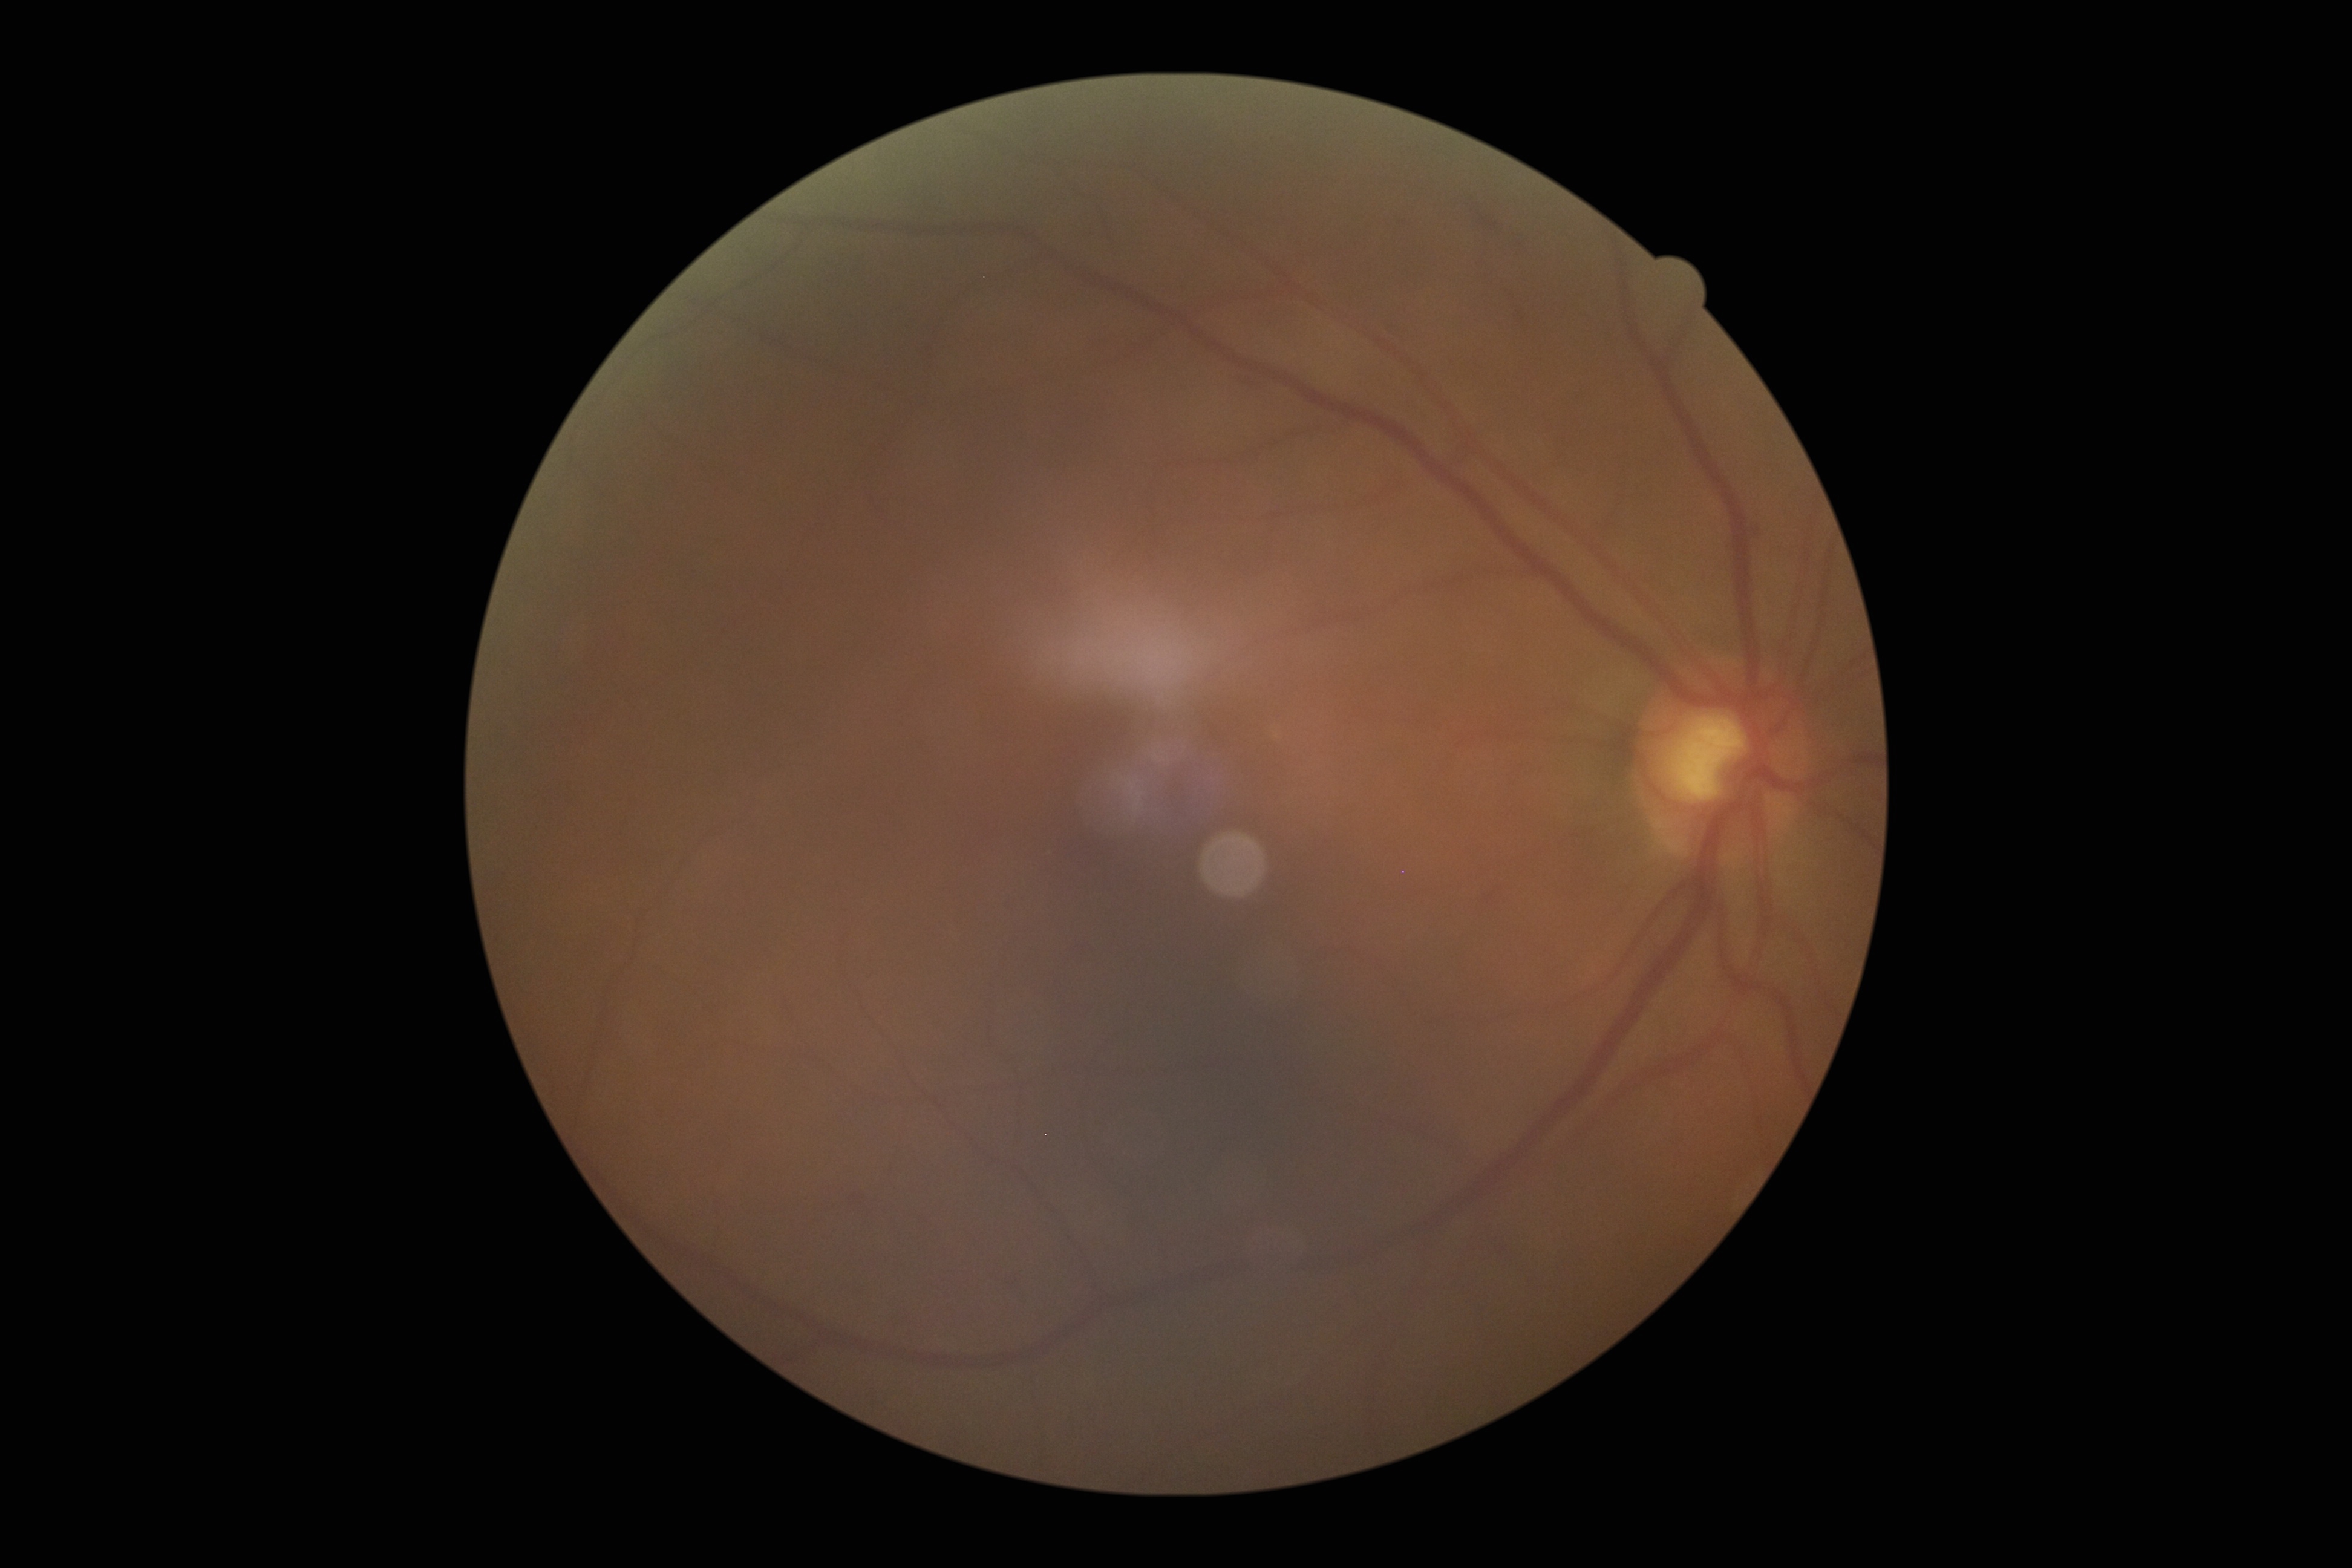 DR grade: 2.